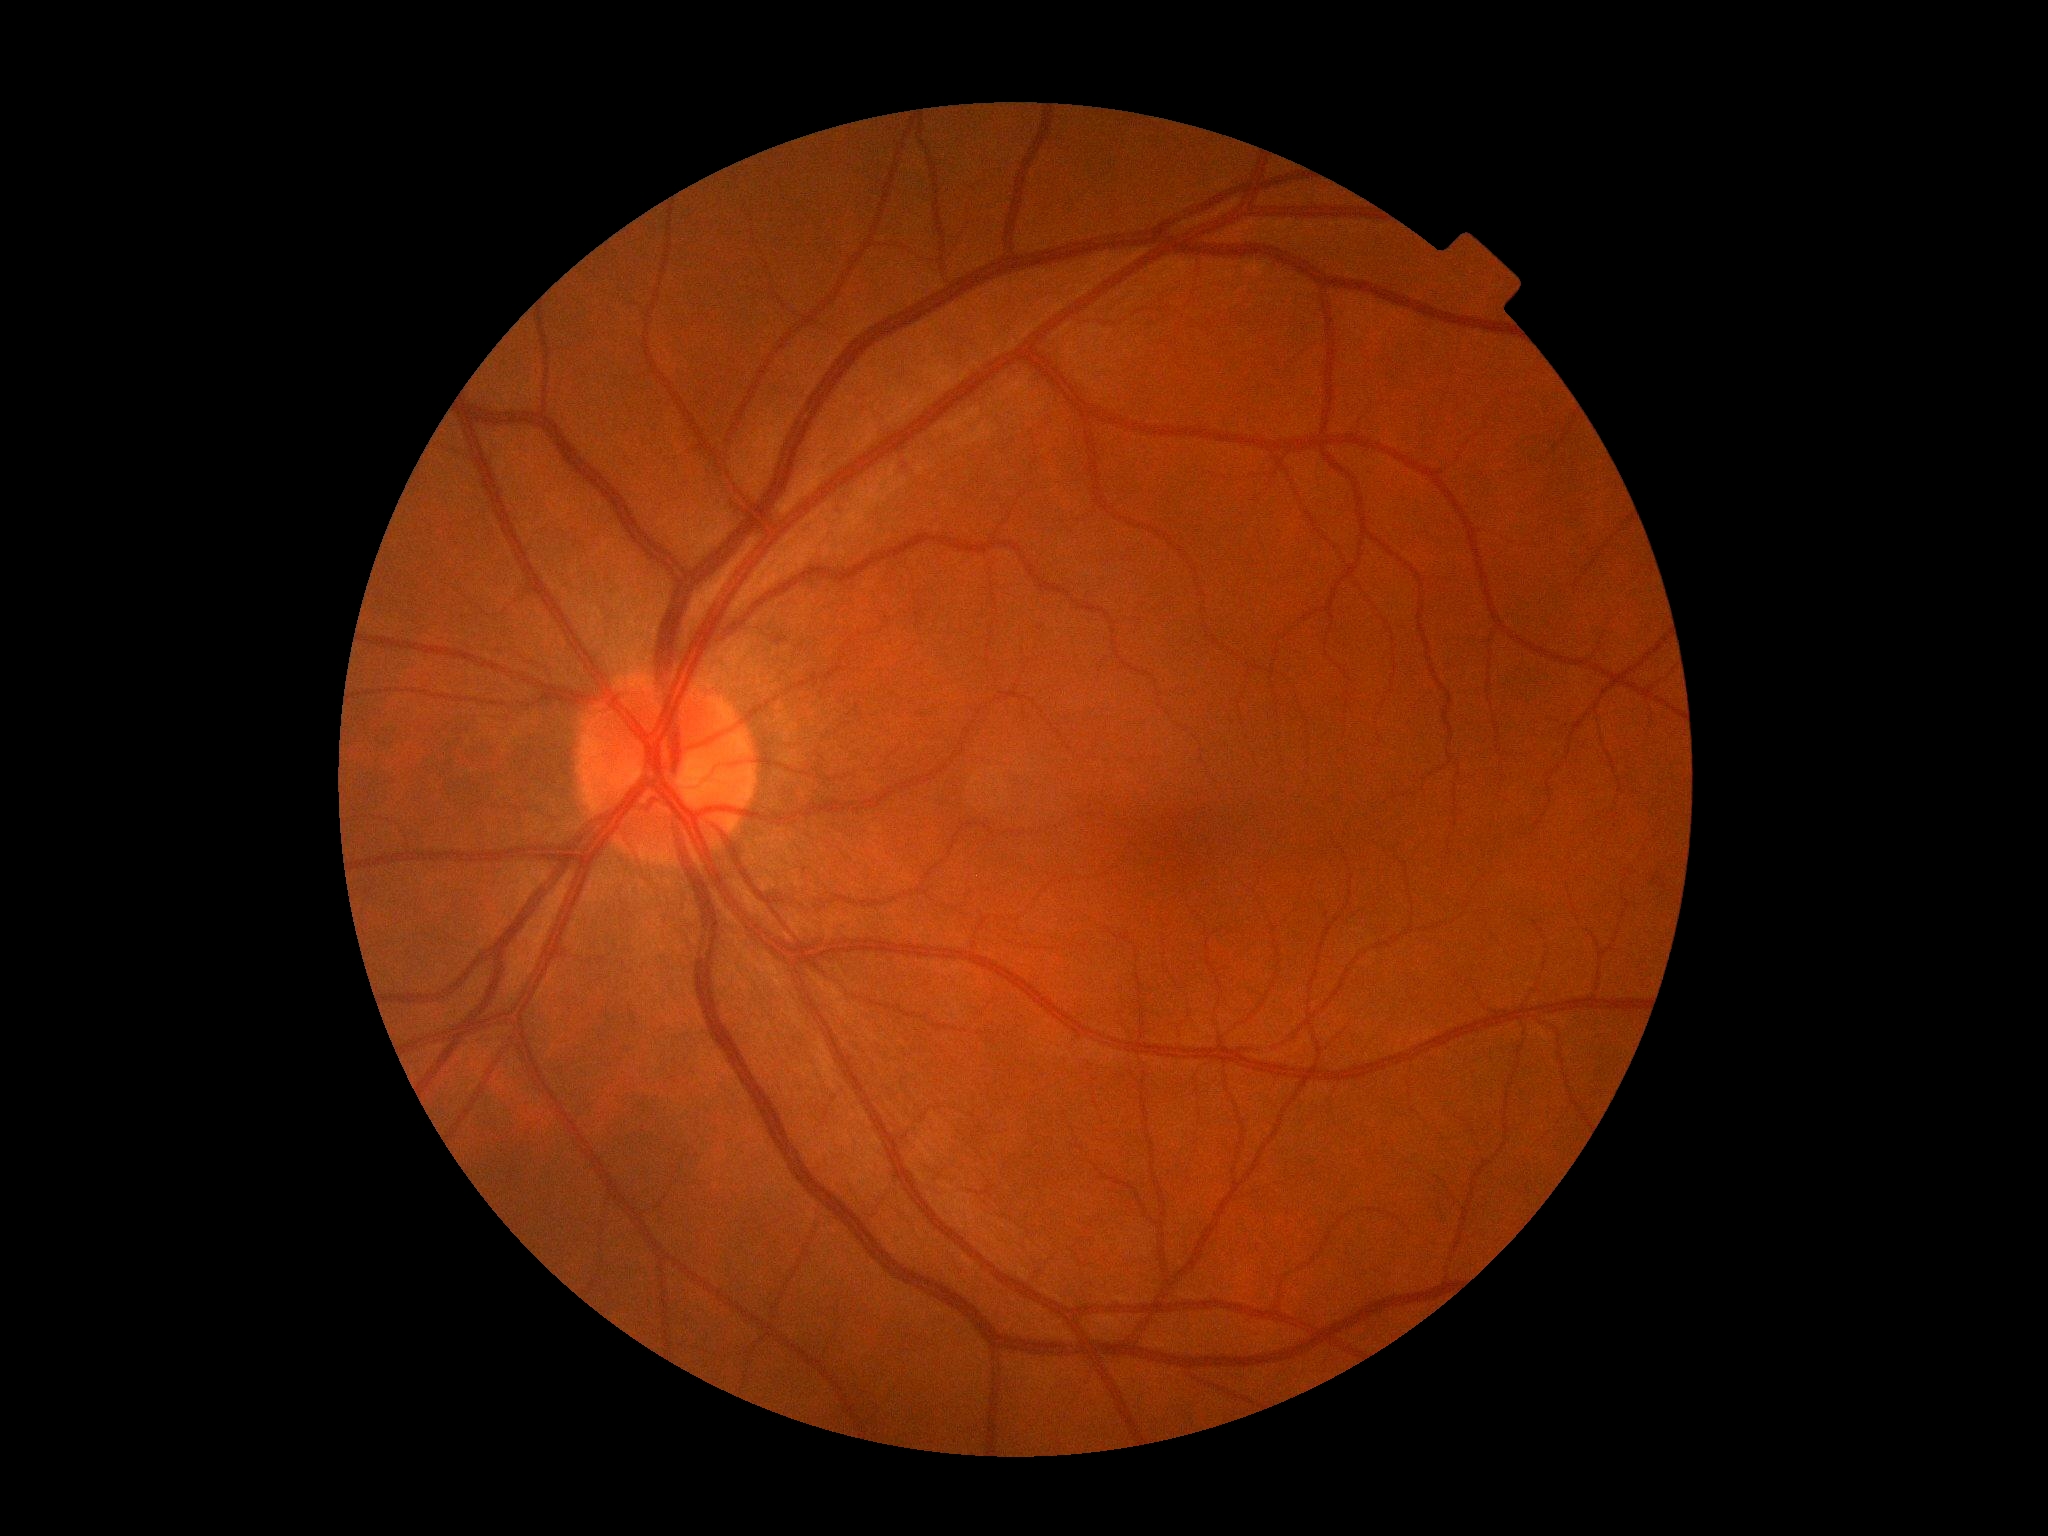 Diabetic retinopathy severity is 0.